2212 x 1659 pixels; color fundus photograph.
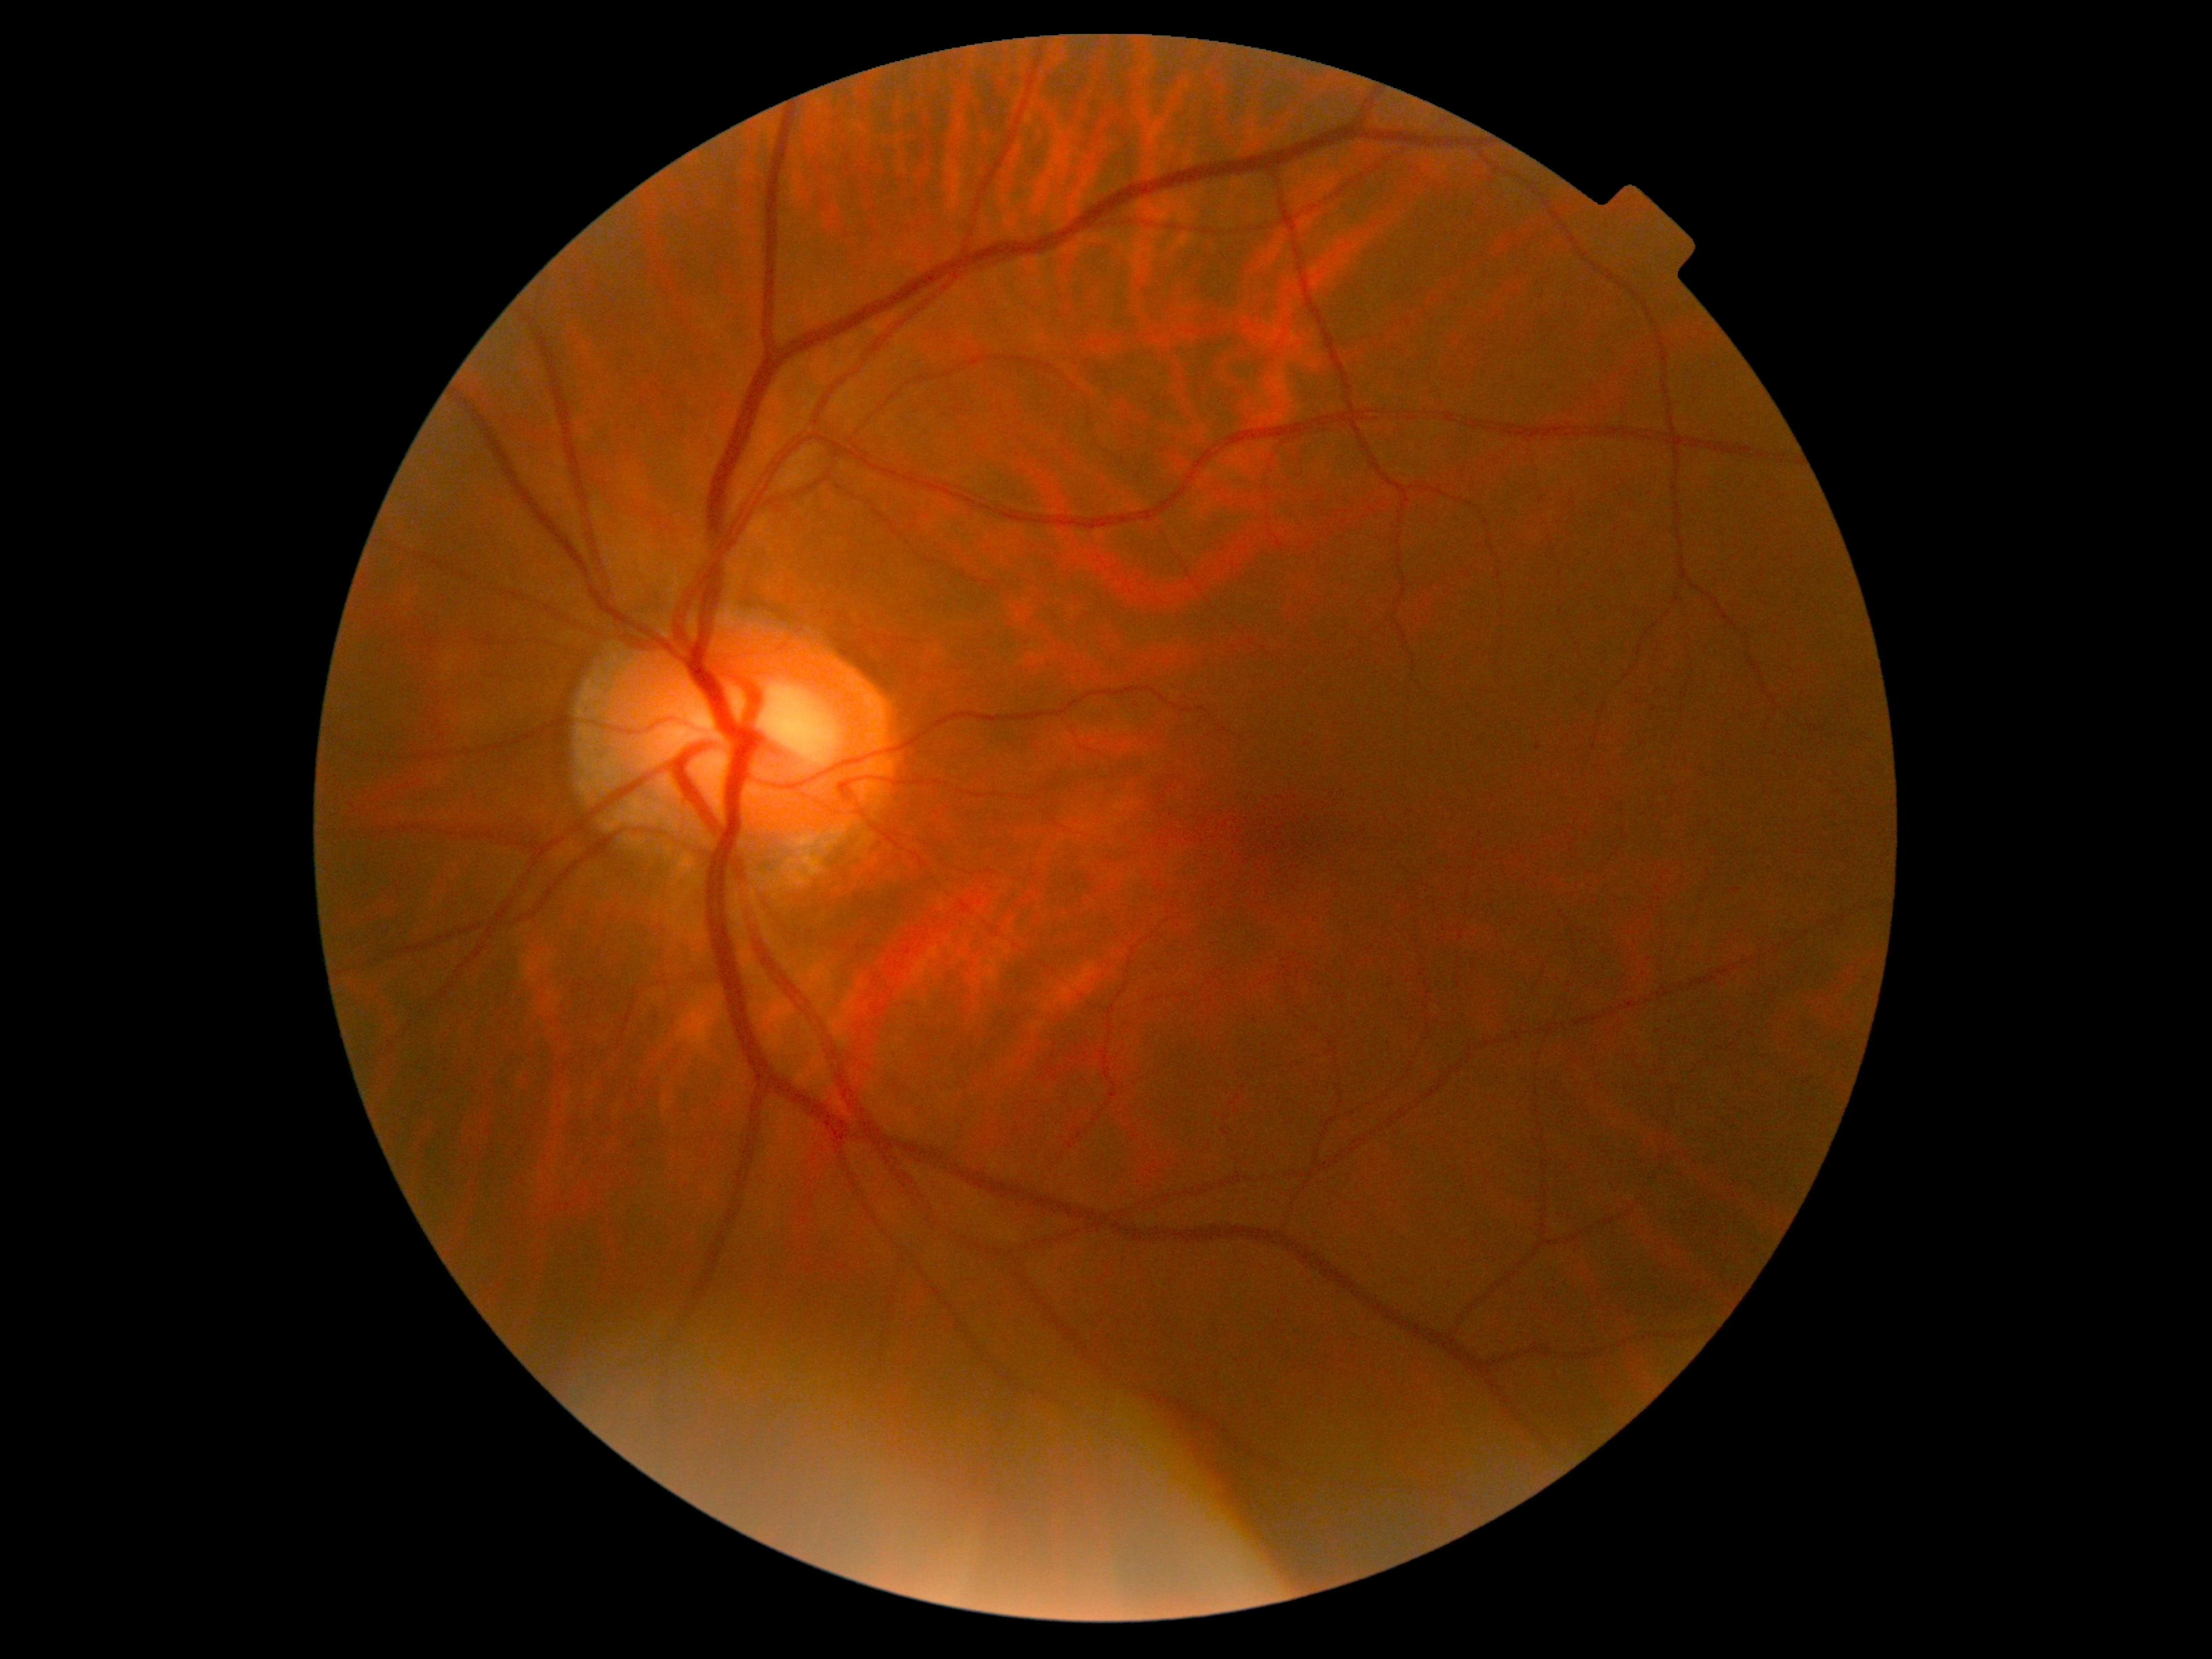

No DR findings.
Diabetic retinopathy: grade 0 (no apparent retinopathy).